Infant wide-field retinal image
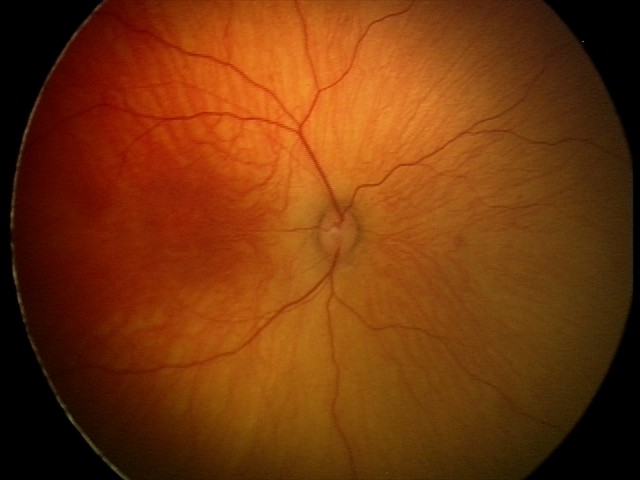

Impression = no abnormalities.